Retinal fundus photograph. 45-degree field of view.
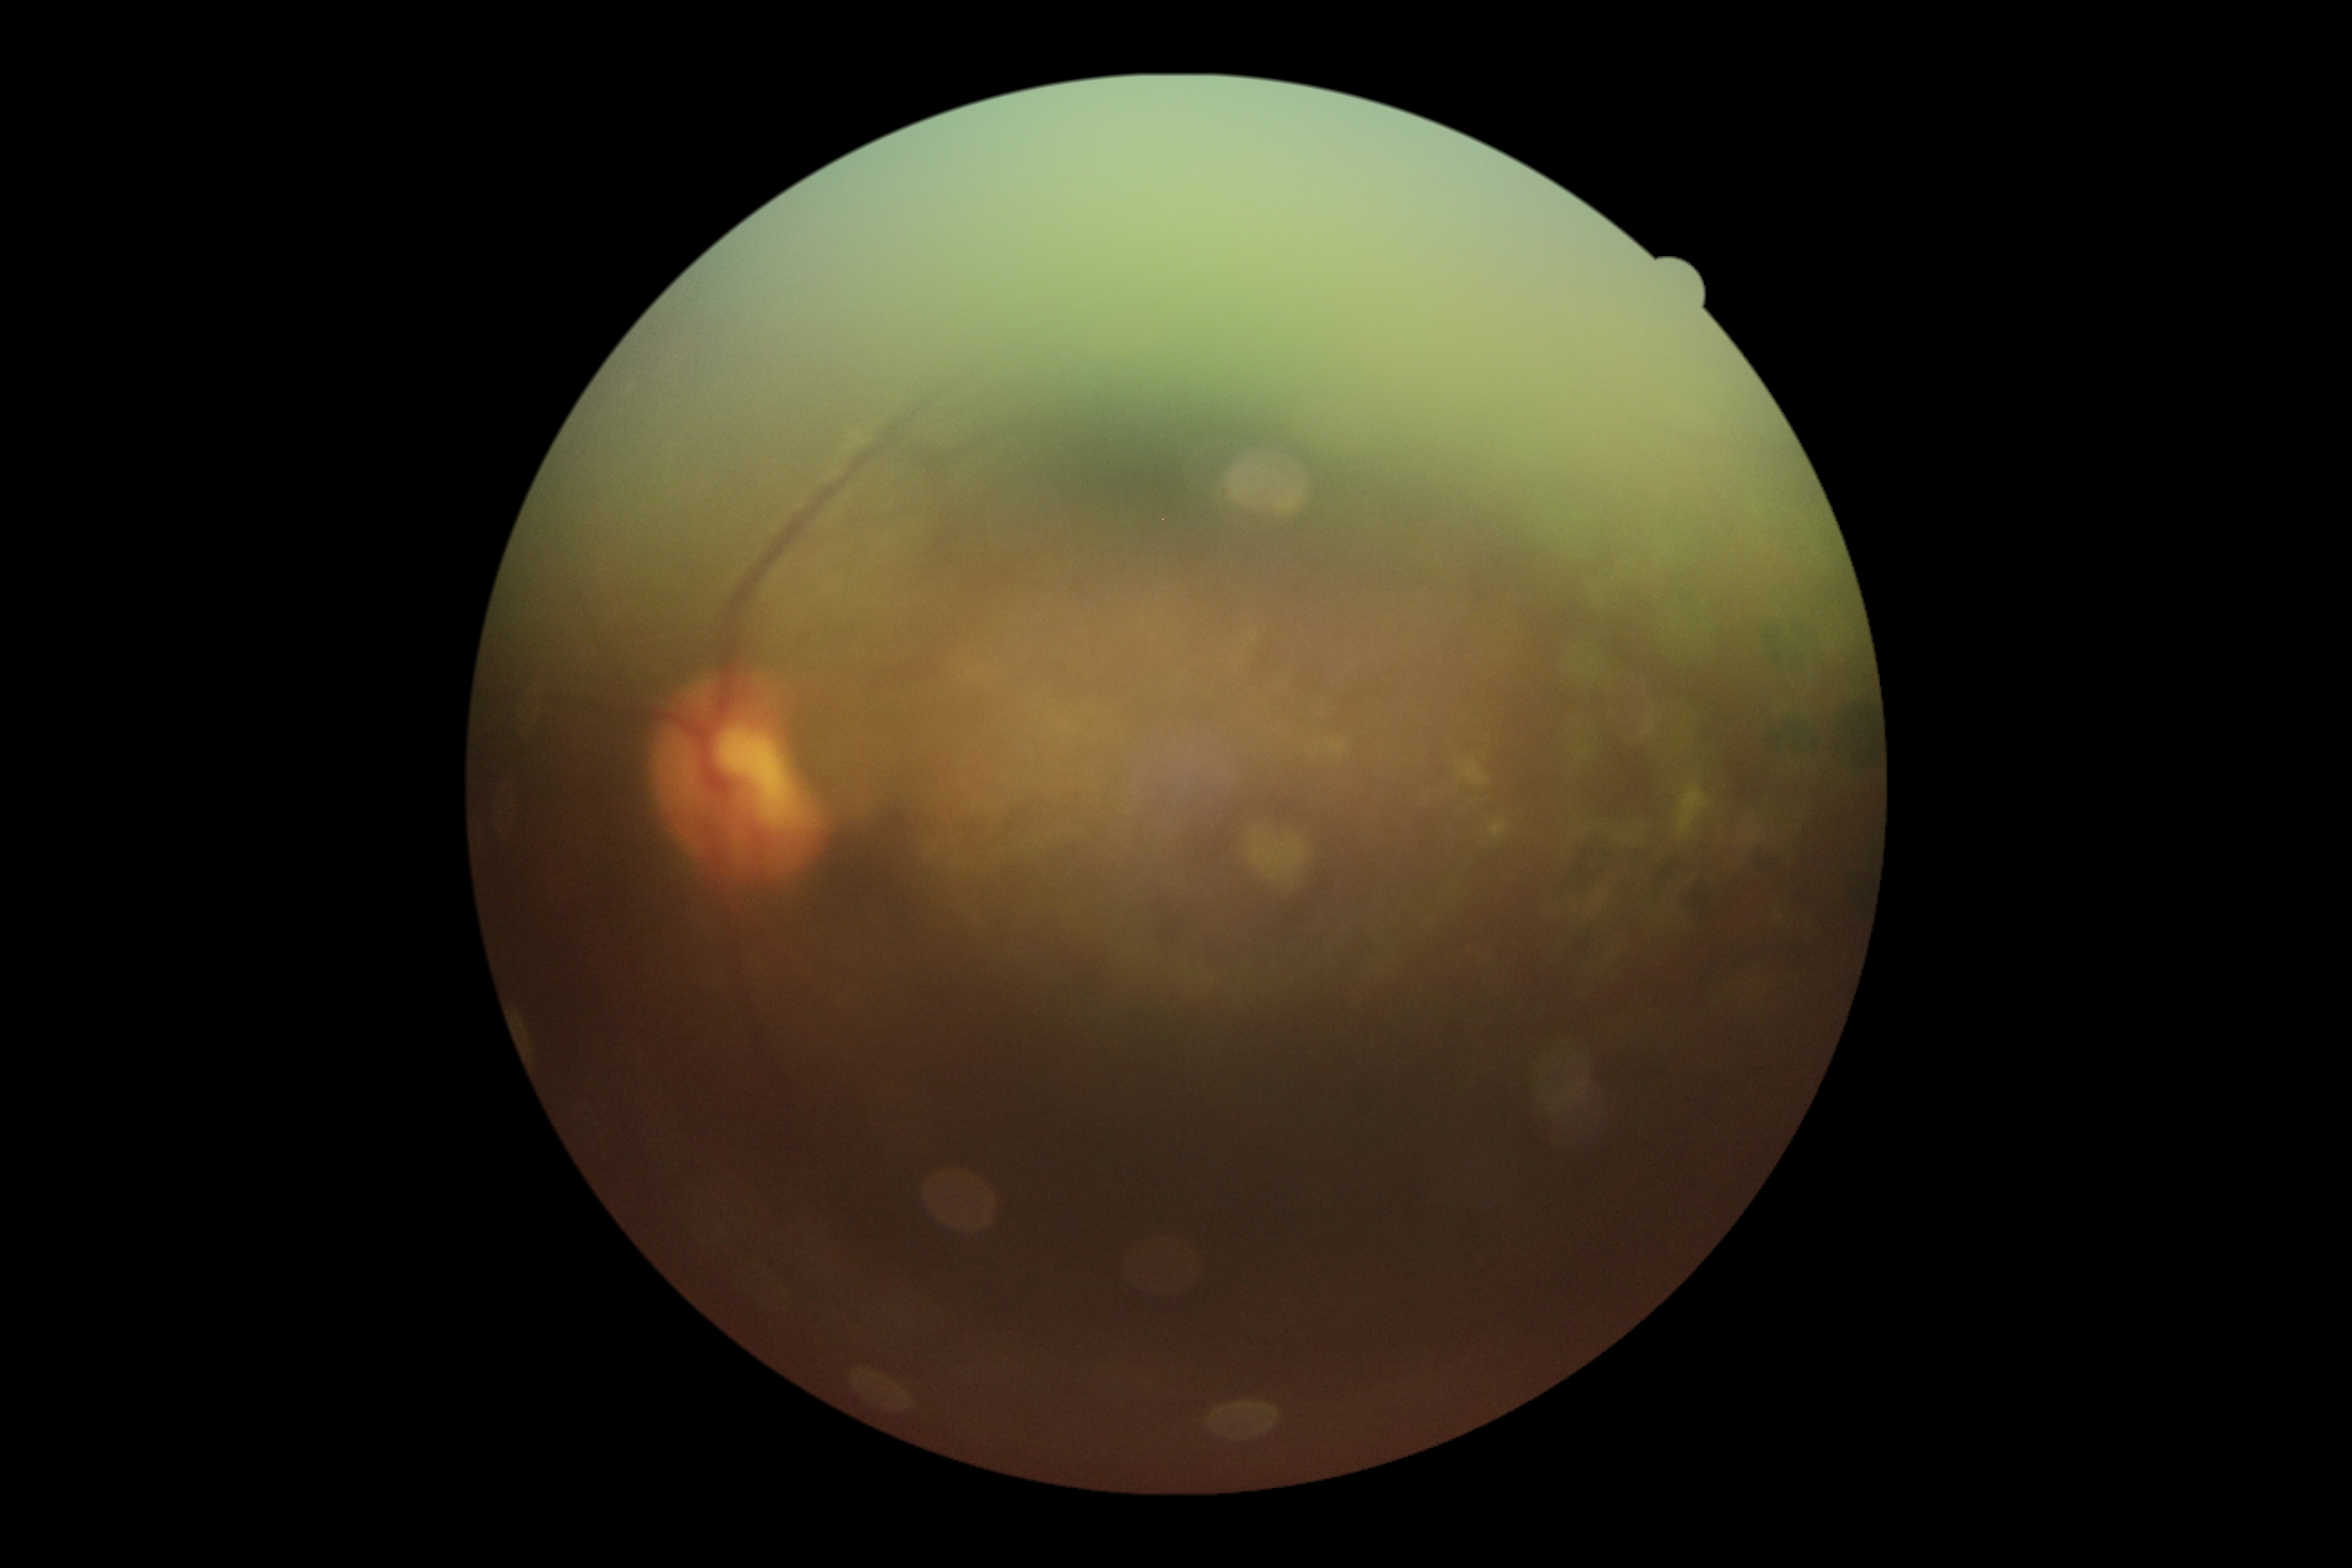

Diabetic retinopathy (DR) is ungradable. The image cannot be graded for diabetic retinopathy.